Wide-field fundus photograph of an infant: 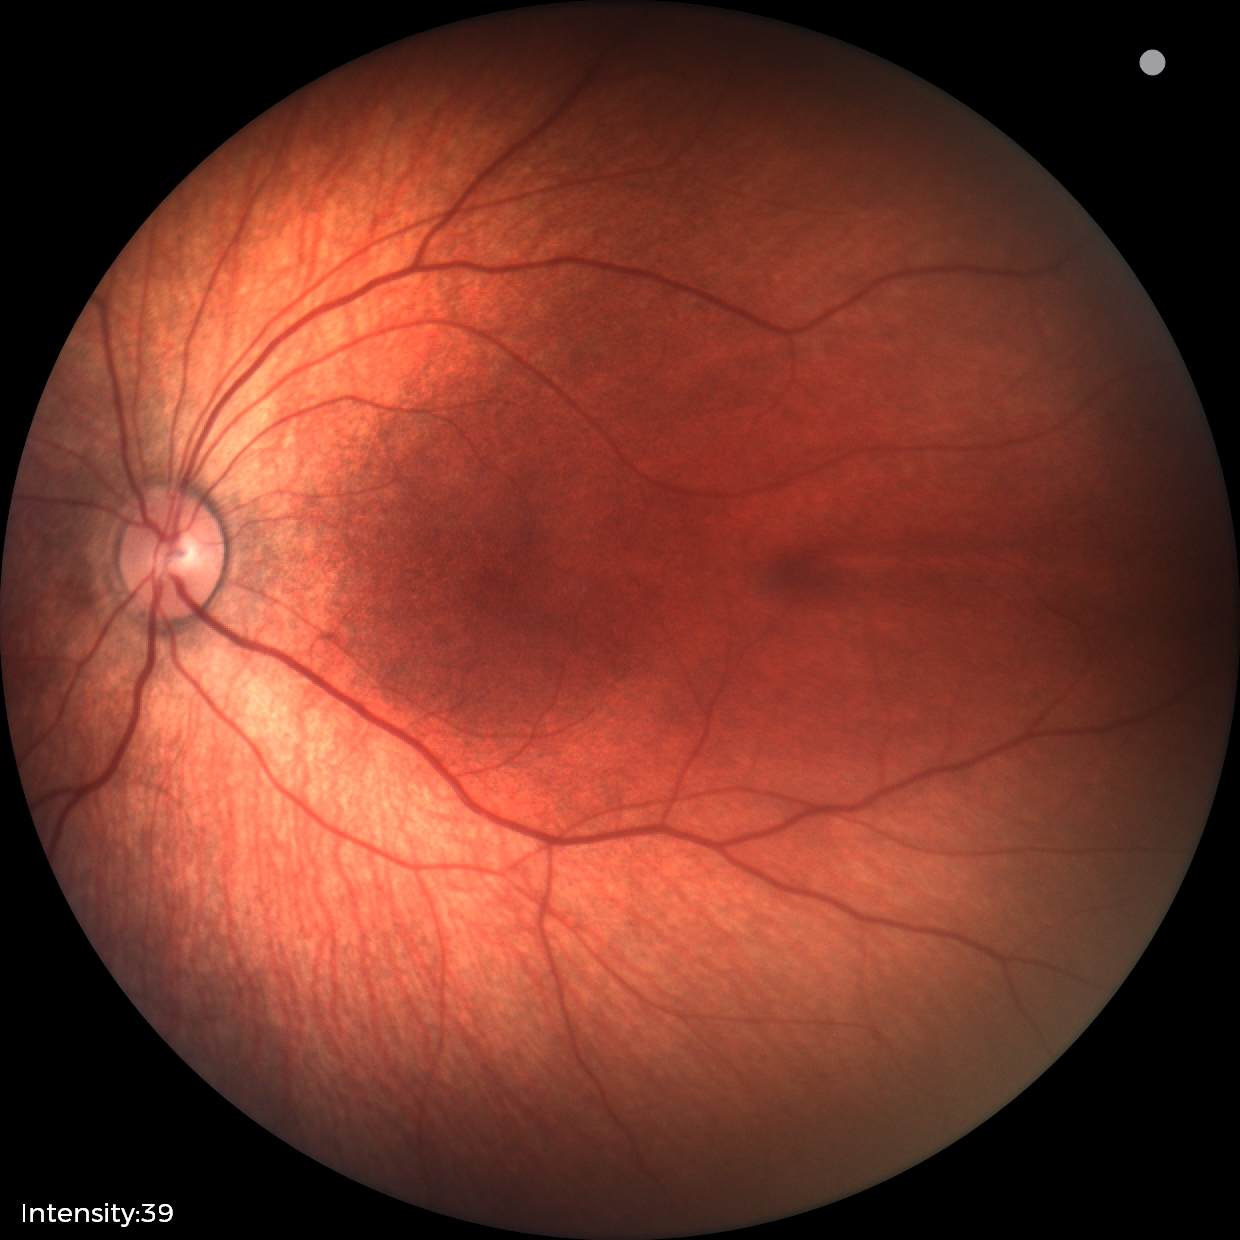
Screening examination diagnosed as physiological.